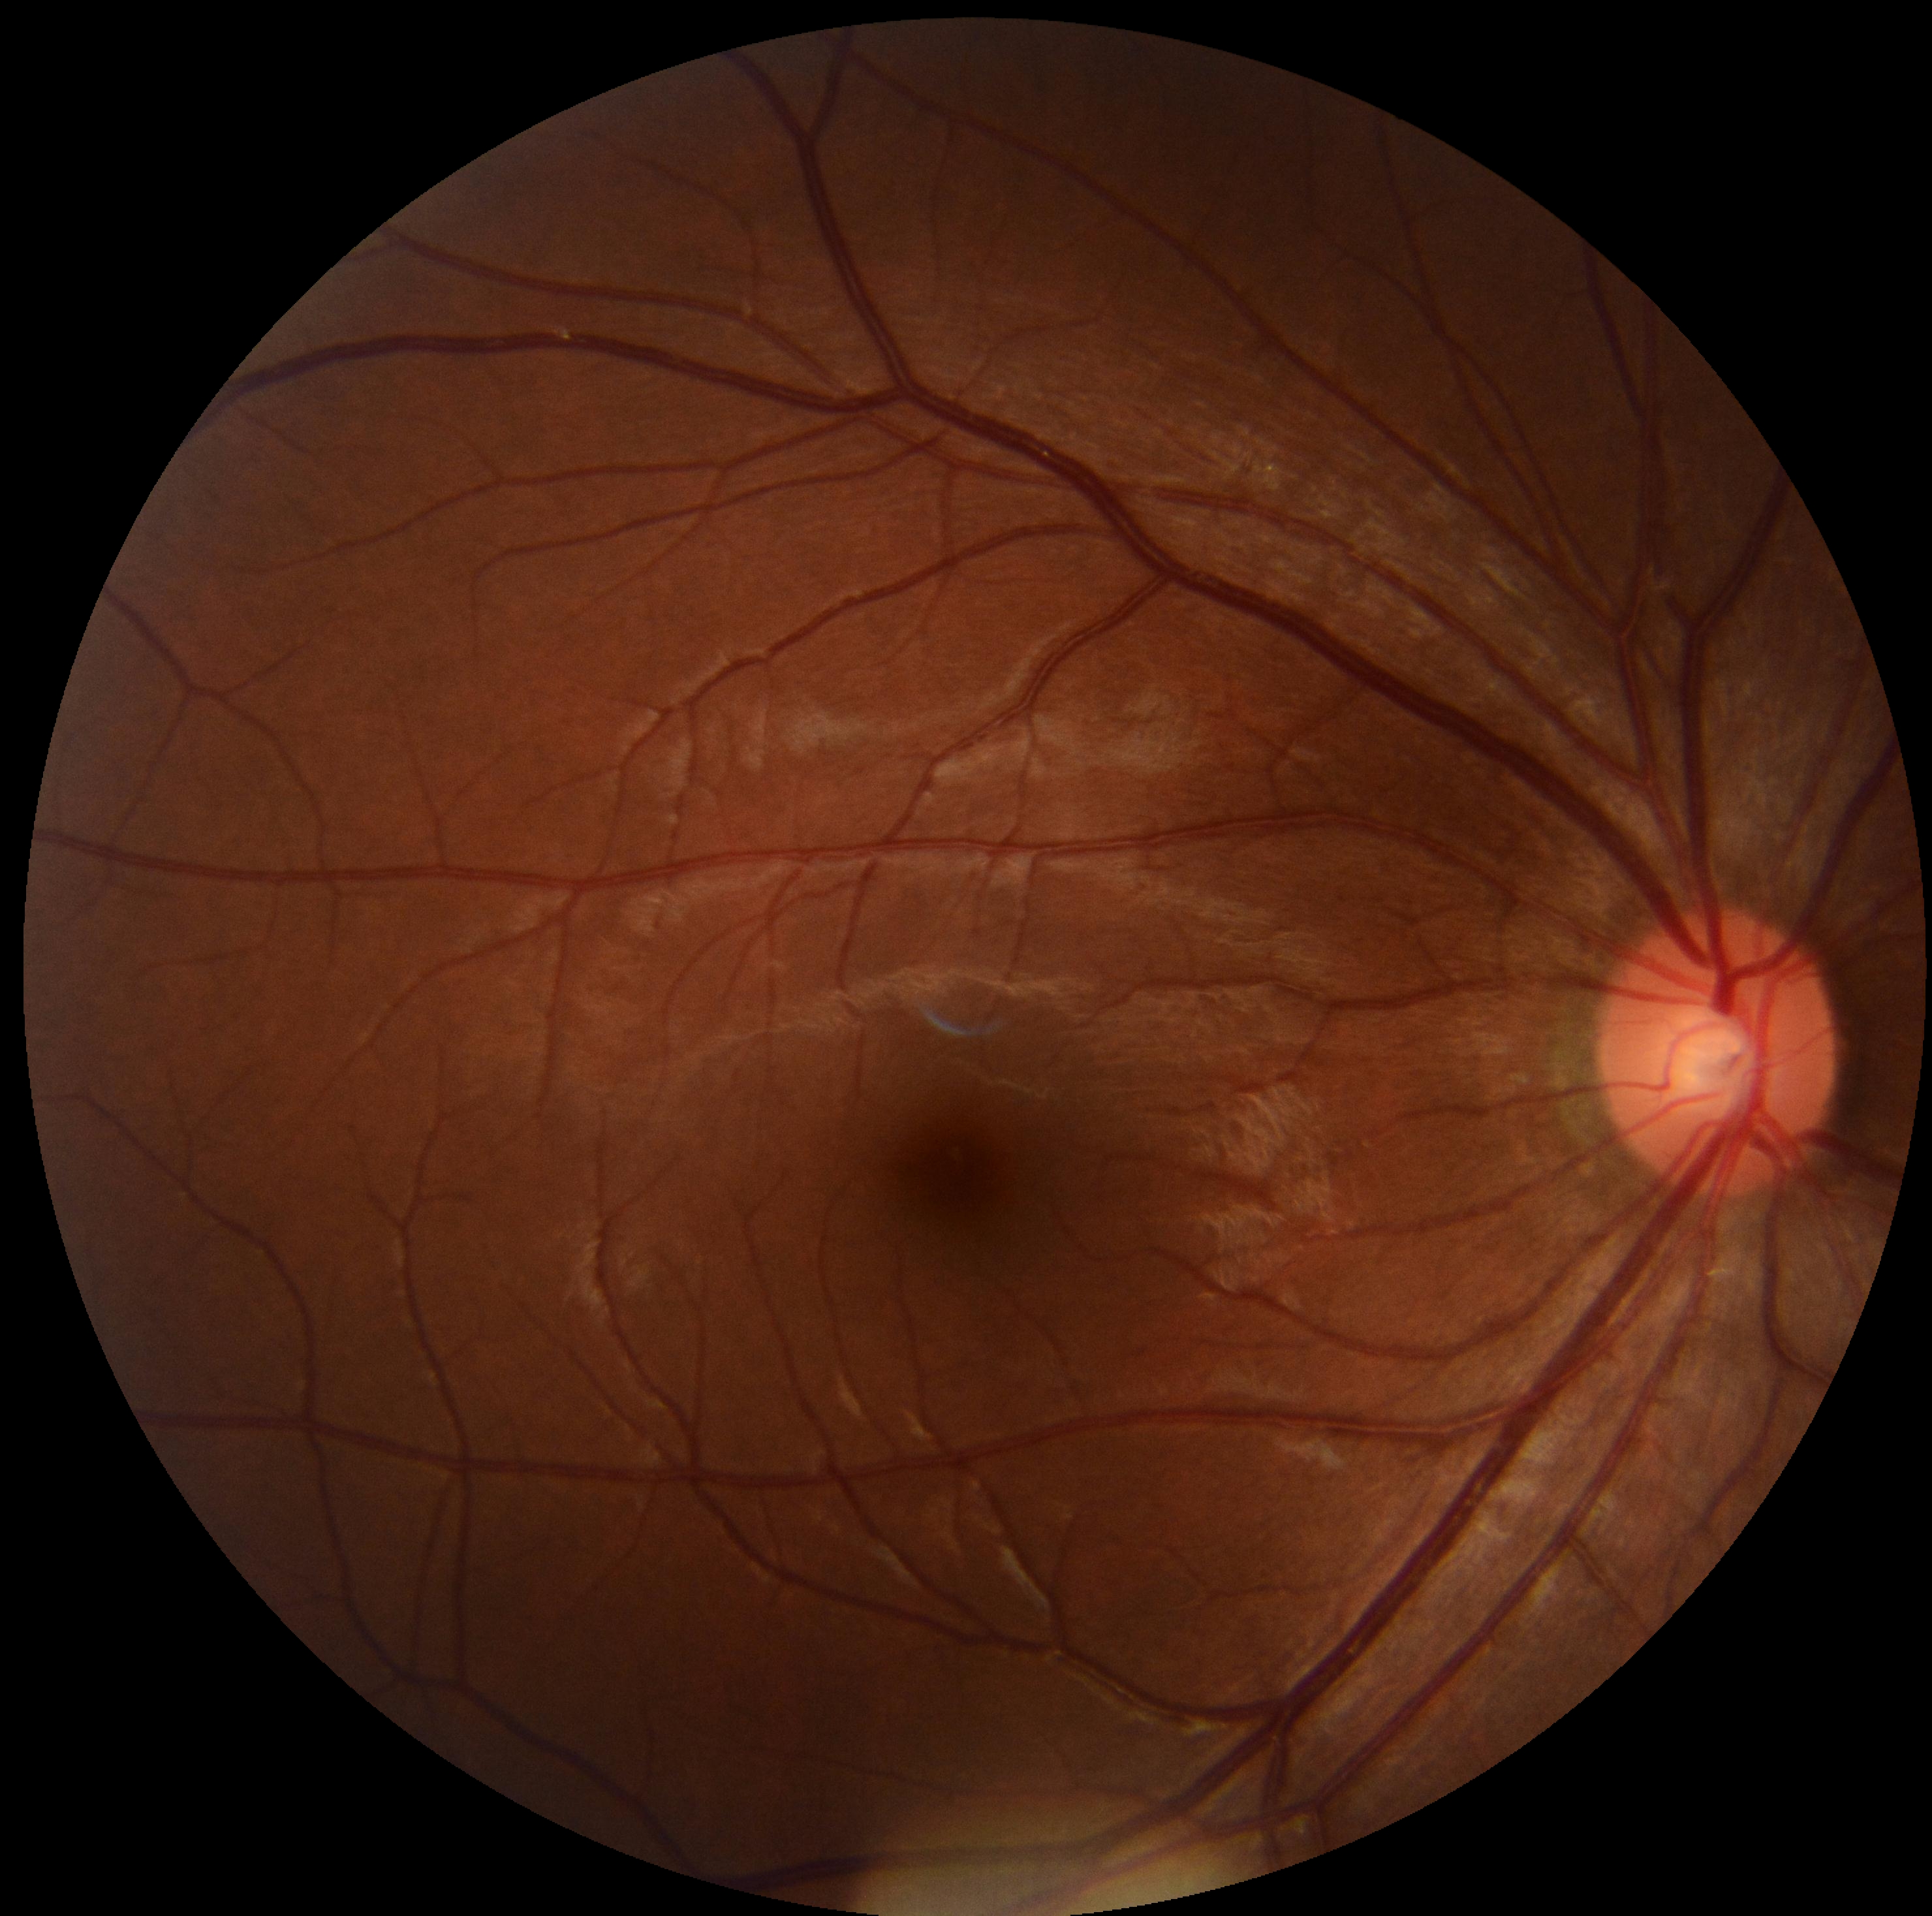

No signs of diabetic retinopathy. DR grade is 0.